Pediatric wide-field fundus photograph:
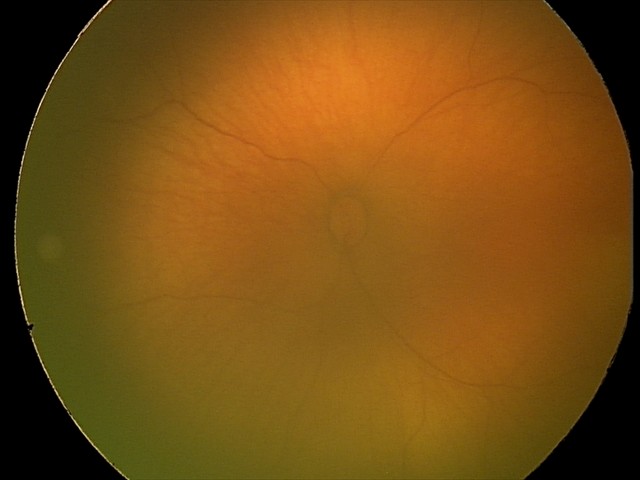

Assessment: no abnormal retinal findings.